Wide-field fundus photograph of an infant — 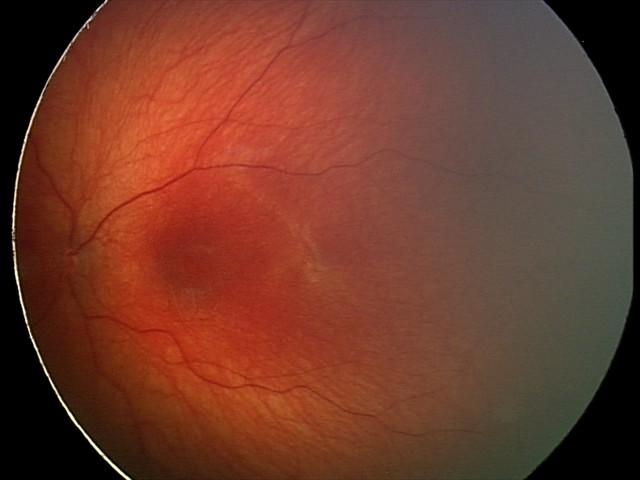 Q: What is the screening diagnosis?
A: physiological finding